Image size 512x512
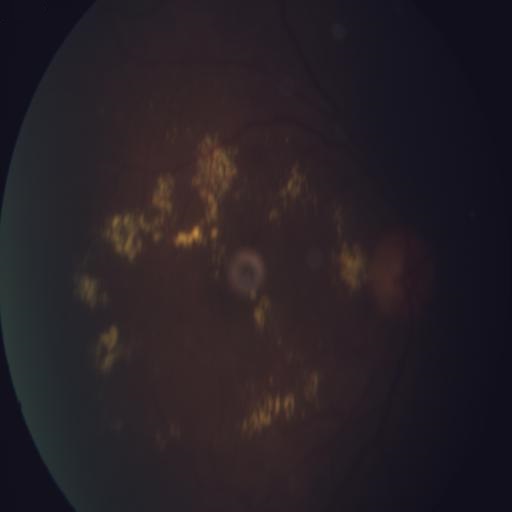

Findings: exudation (EDN).